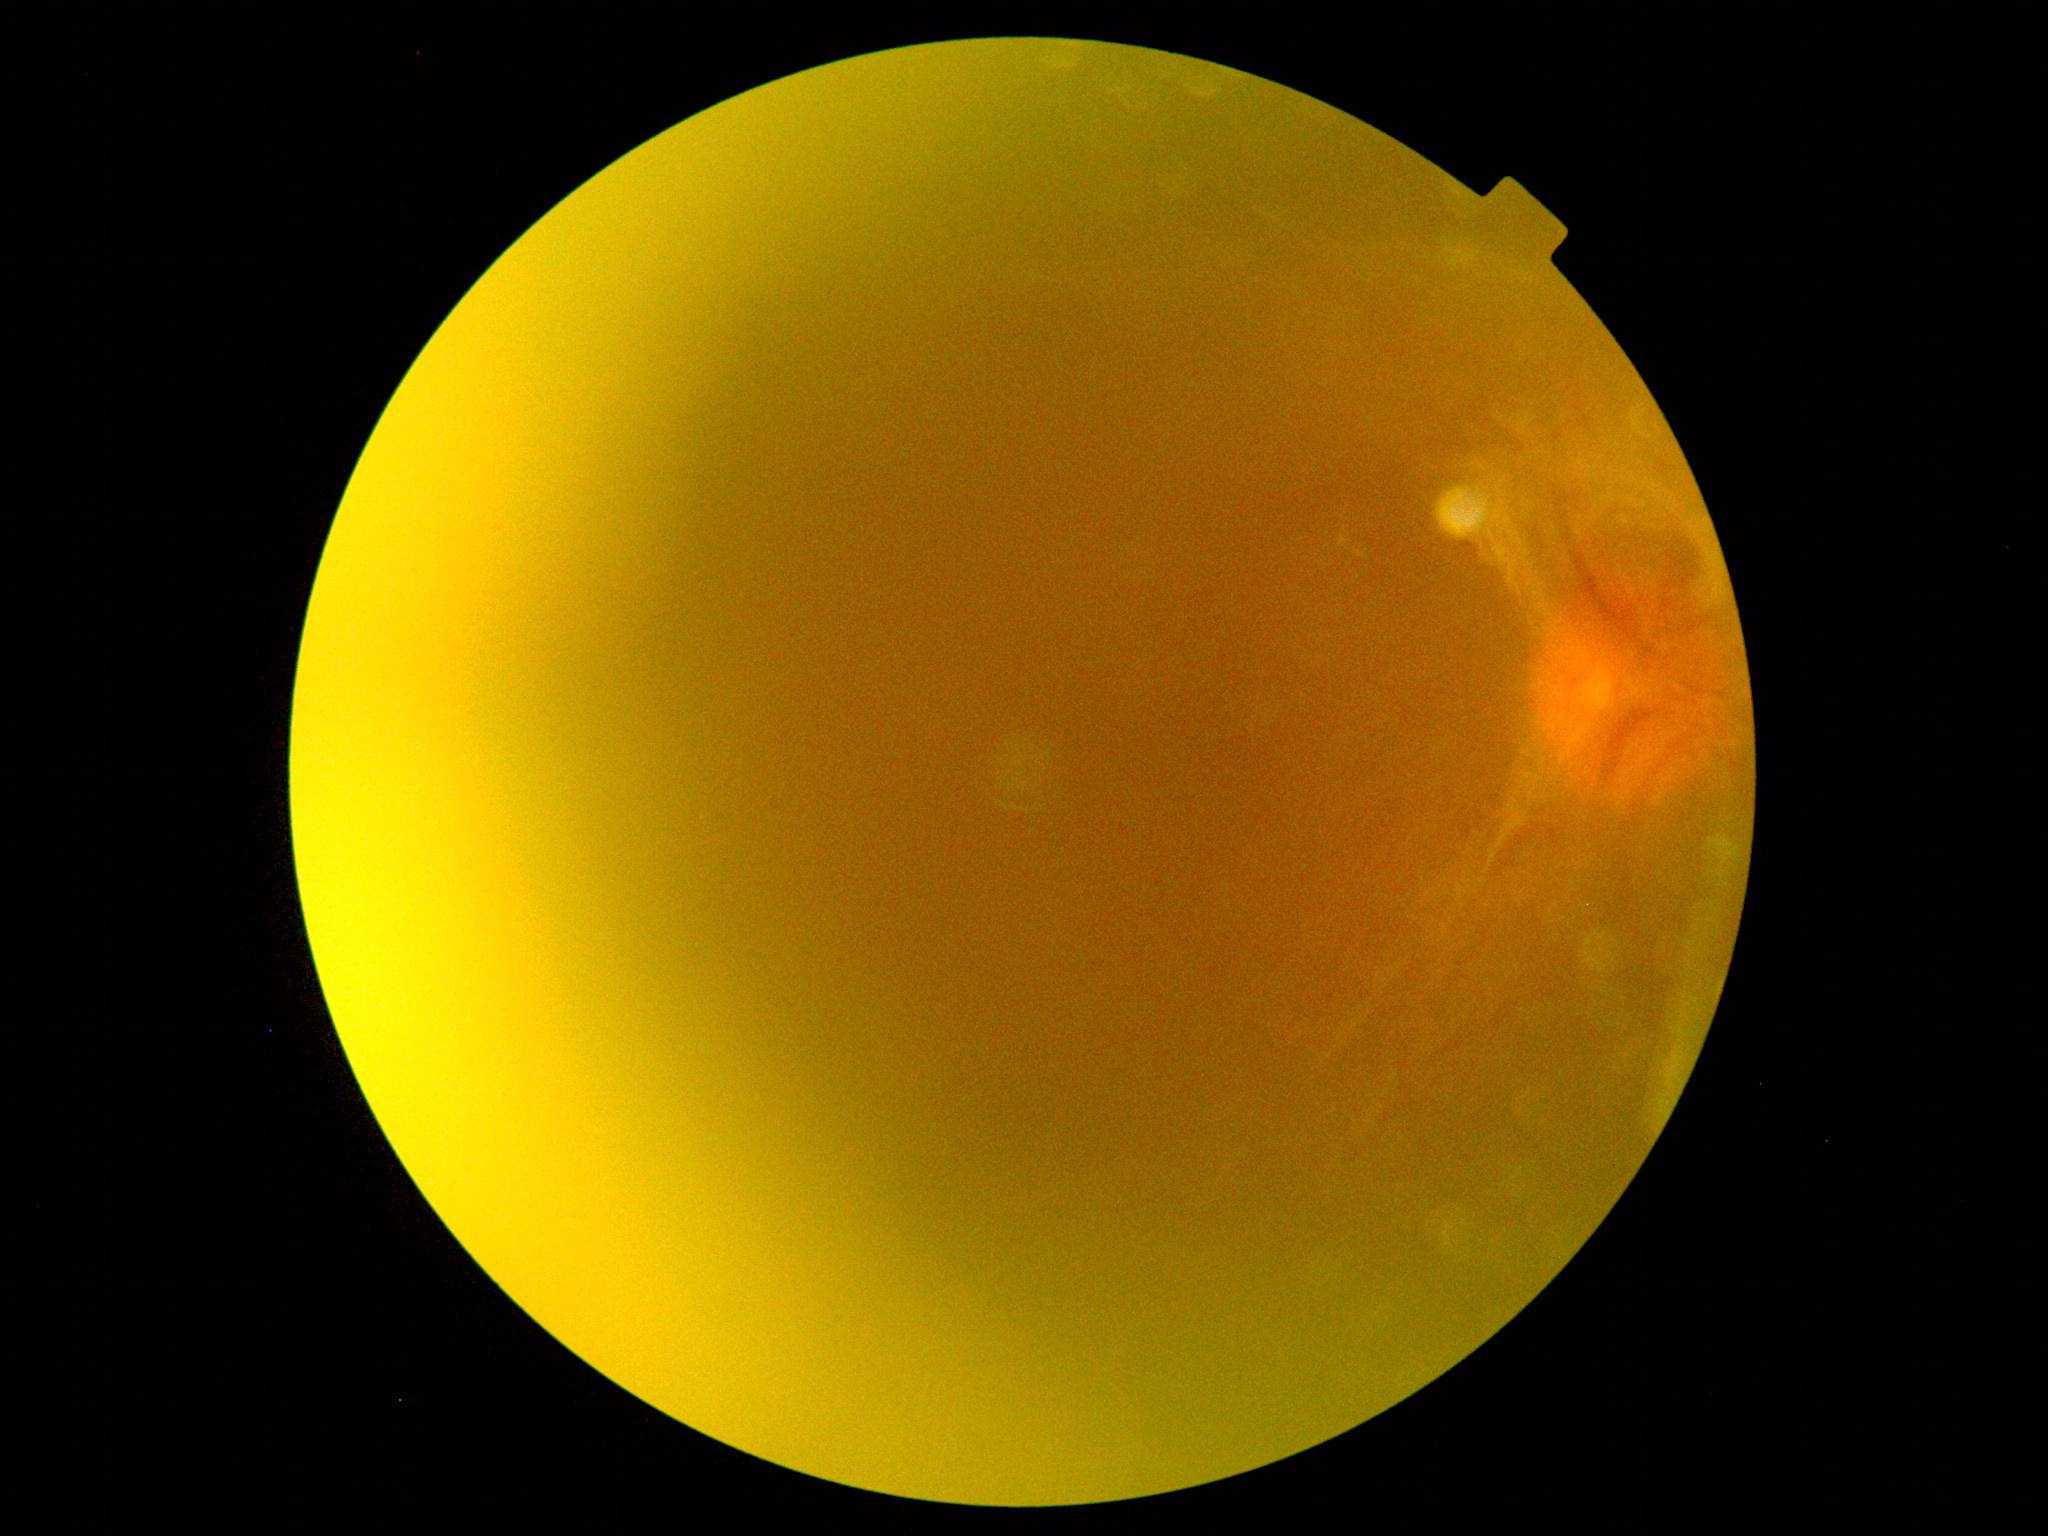 Retinopathy grade: 4.